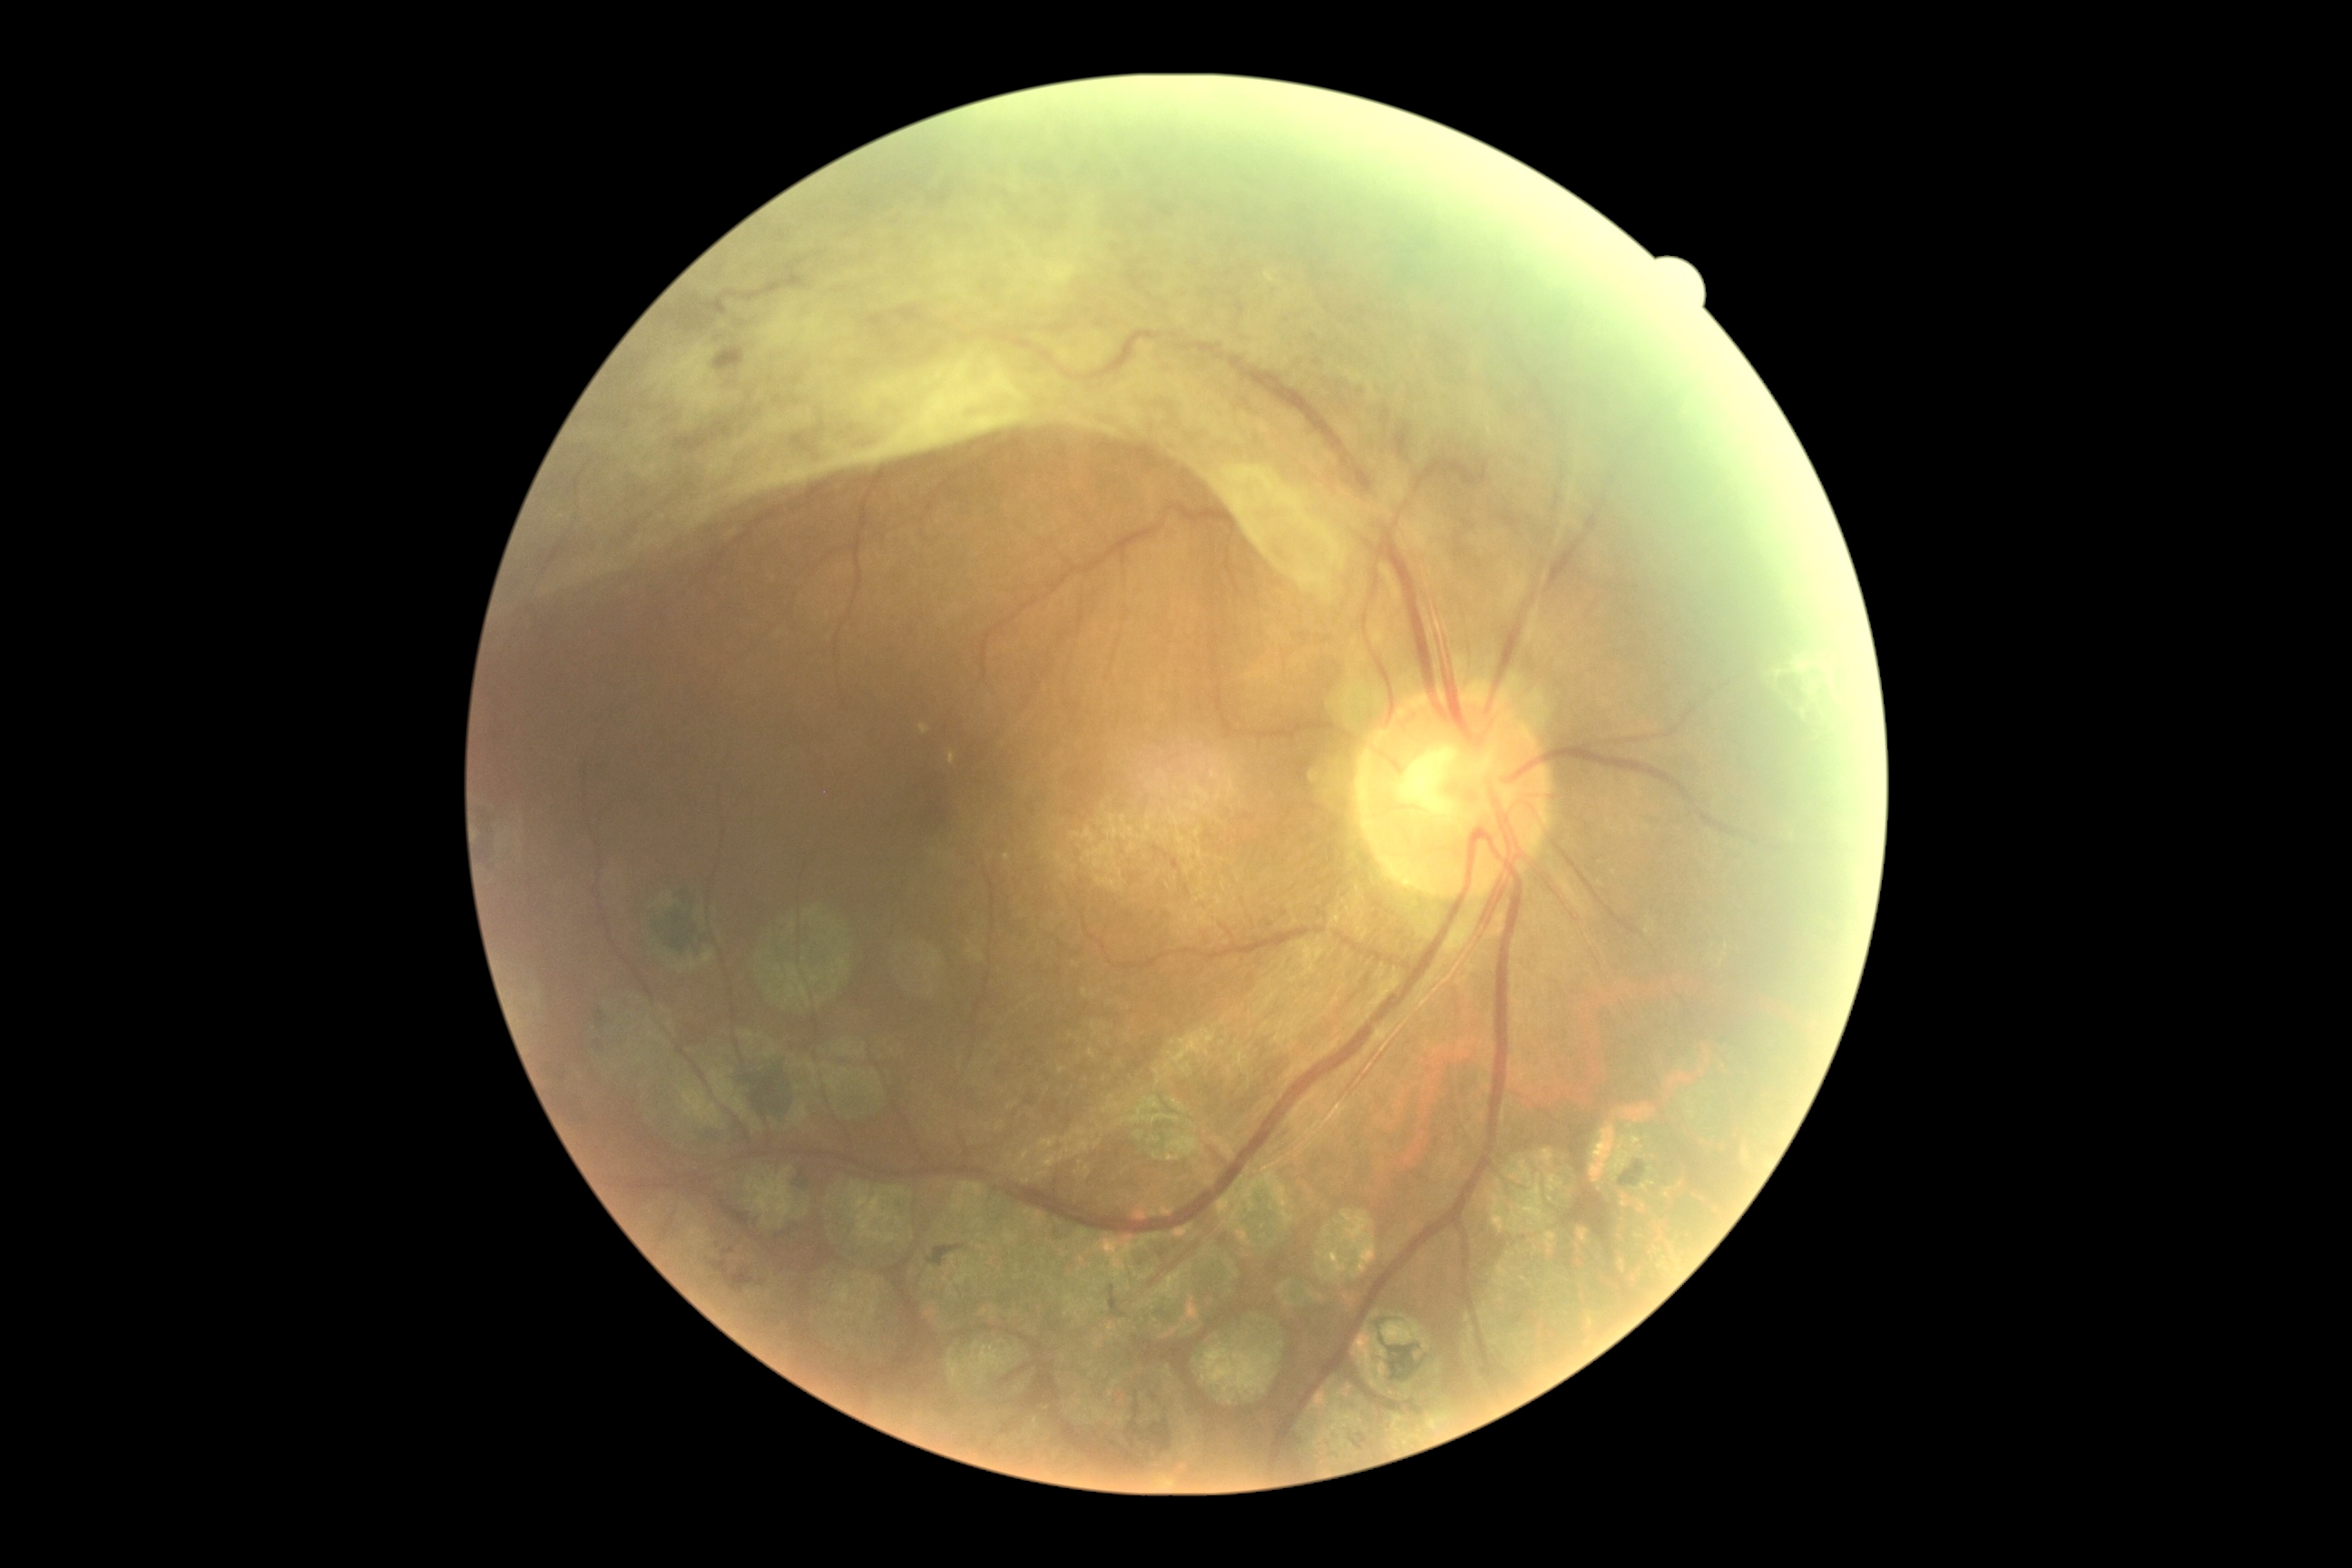

Retinopathy grade is 4.